Acquired with a NIDEK AFC-230. 45 degree fundus photograph:
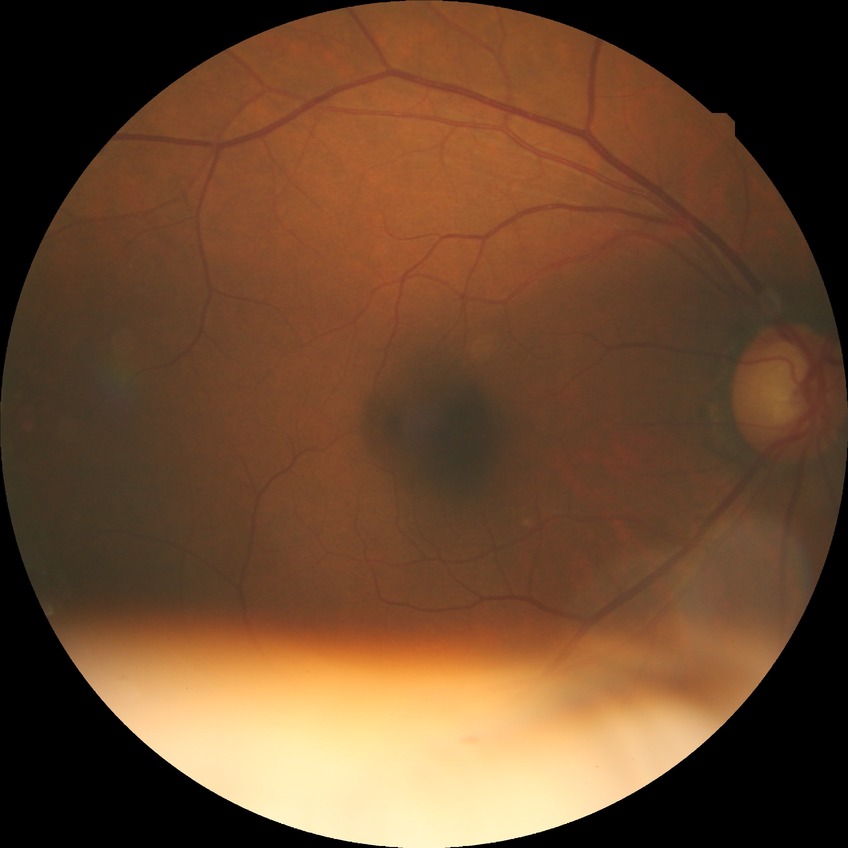
diabetic retinopathy (DR) = NDR (no diabetic retinopathy).